Retinal fundus photograph · 2048 by 1536 pixels · 45° field of view
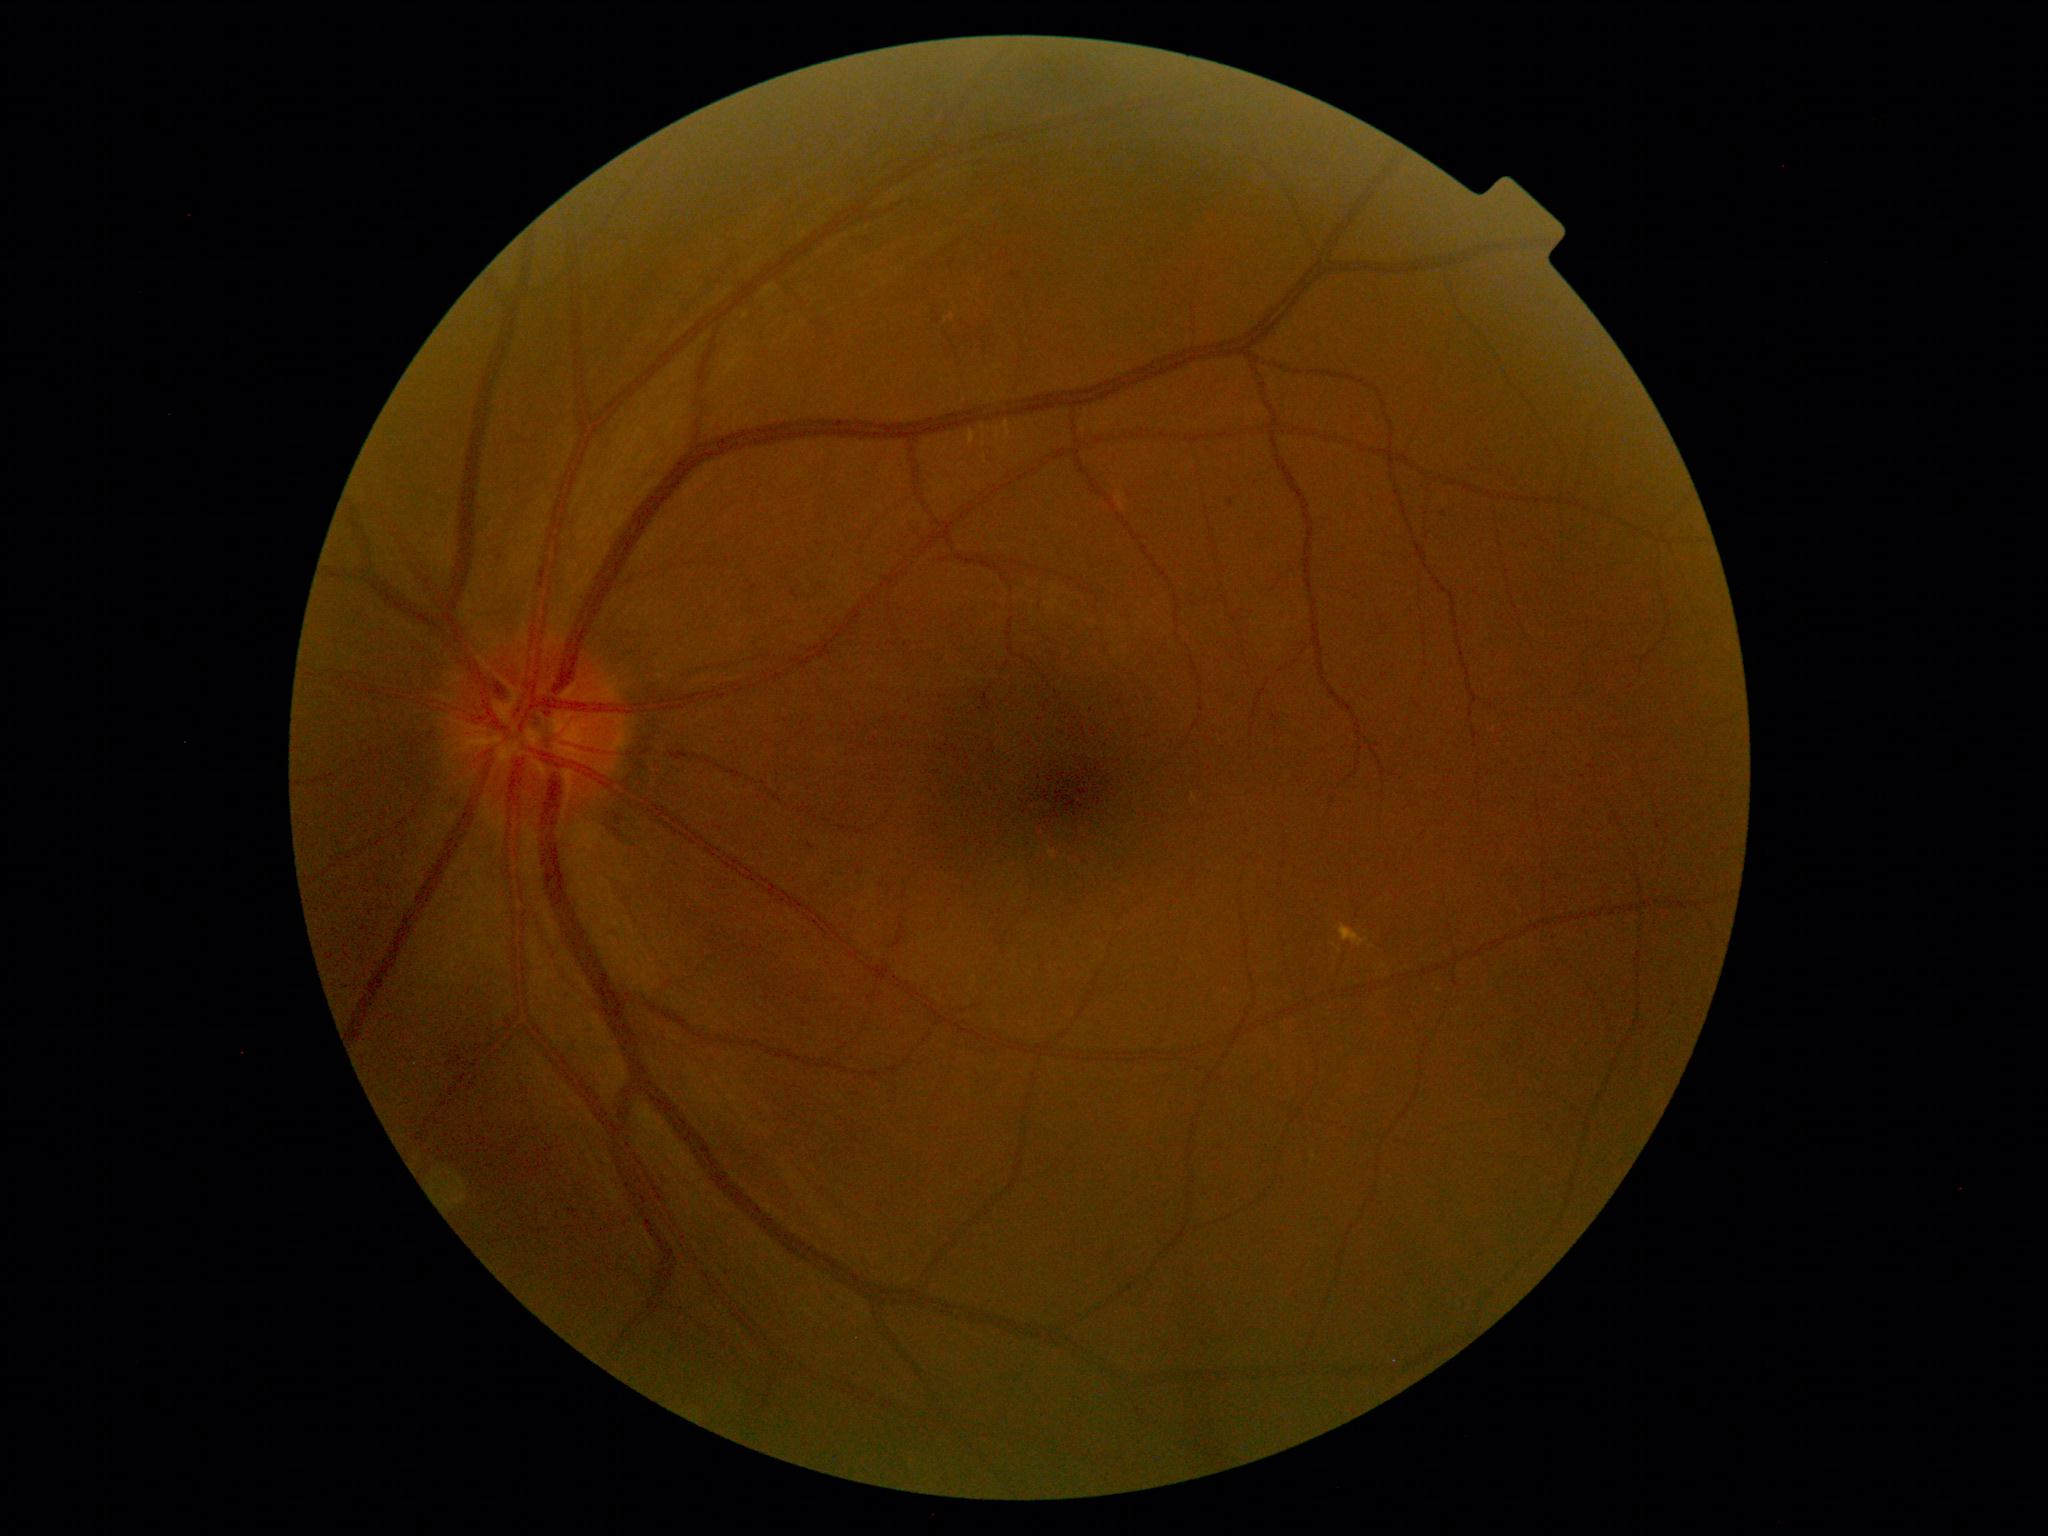

Diabetic retinopathy grade is 2 (moderate NPDR) — more than just microaneurysms but less than severe NPDR
Lesions:
* soft exudates: none identified
* microaneurysms: (x1=949, y1=261, x2=954, y2=269) | (x1=1229, y1=498, x2=1235, y2=507)
* Smaller microaneurysms around 1444, 514 | 1013, 275
* Smaller hemorrhages around 811, 846
* hard exudates: (x1=983, y1=438, x2=989, y2=457) | (x1=1004, y1=422, x2=1011, y2=438) | (x1=1339, y1=924, x2=1369, y2=947) | (x1=969, y1=431, x2=976, y2=445) | (x1=944, y1=315, x2=954, y2=321)
* Smaller hard exudates around 983, 427 | 998, 427 | 998, 436